Wide-field fundus photograph from neonatal ROP screening — 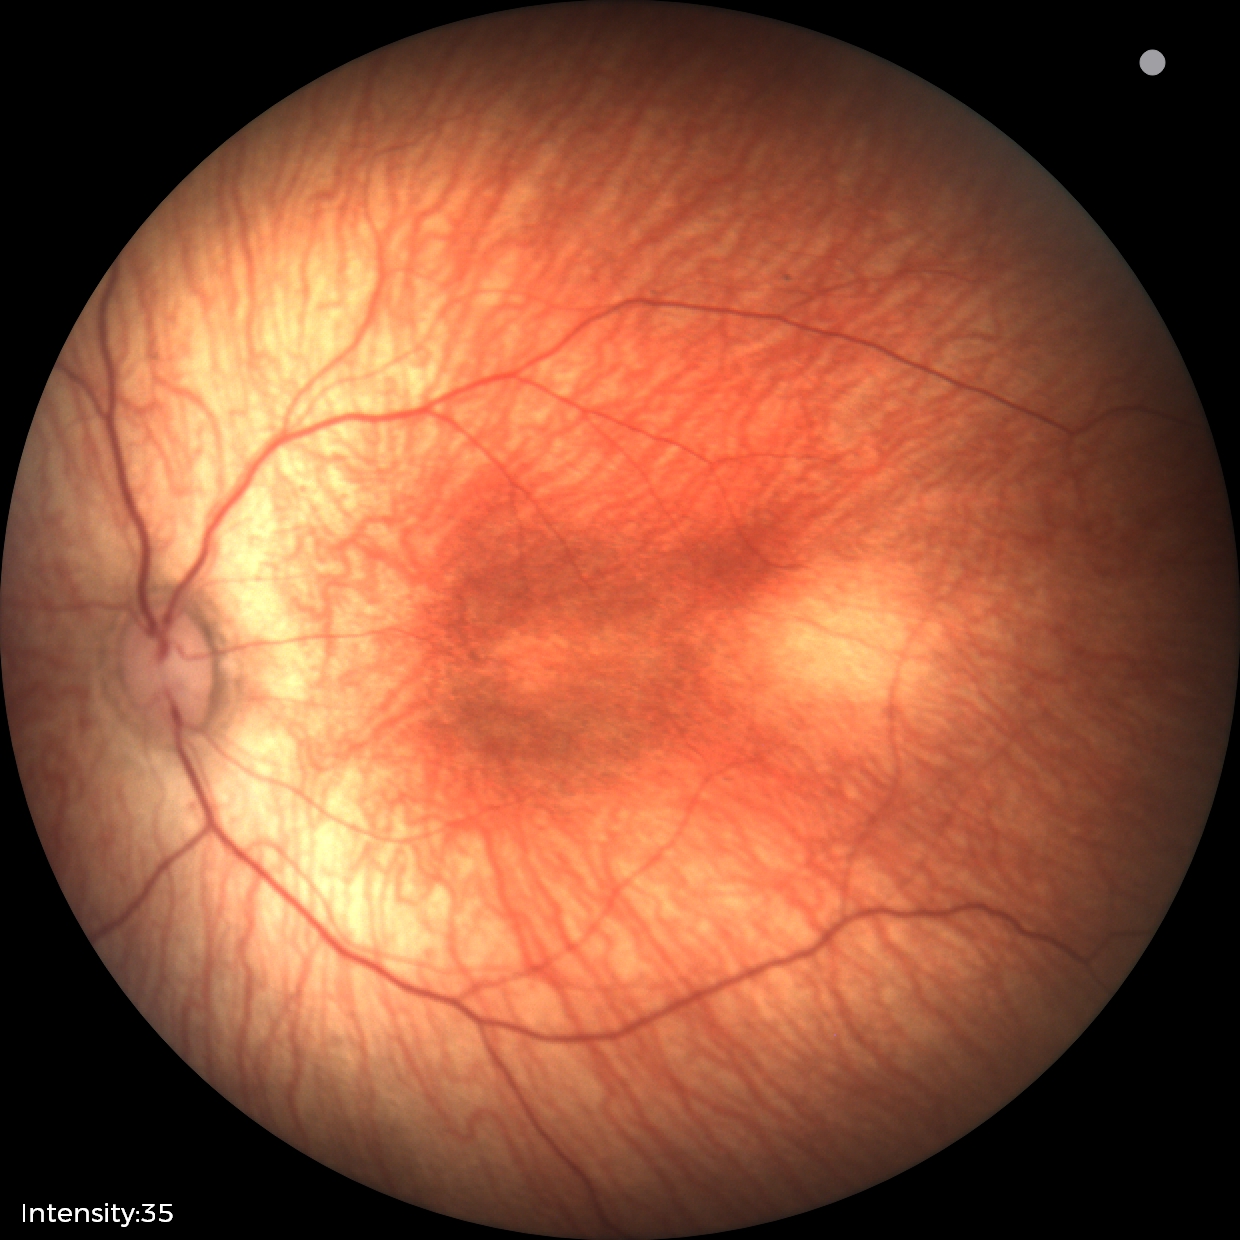
Screening examination consistent with status post retinopathy of prematurity. Without plus disease.